Fundus photo — 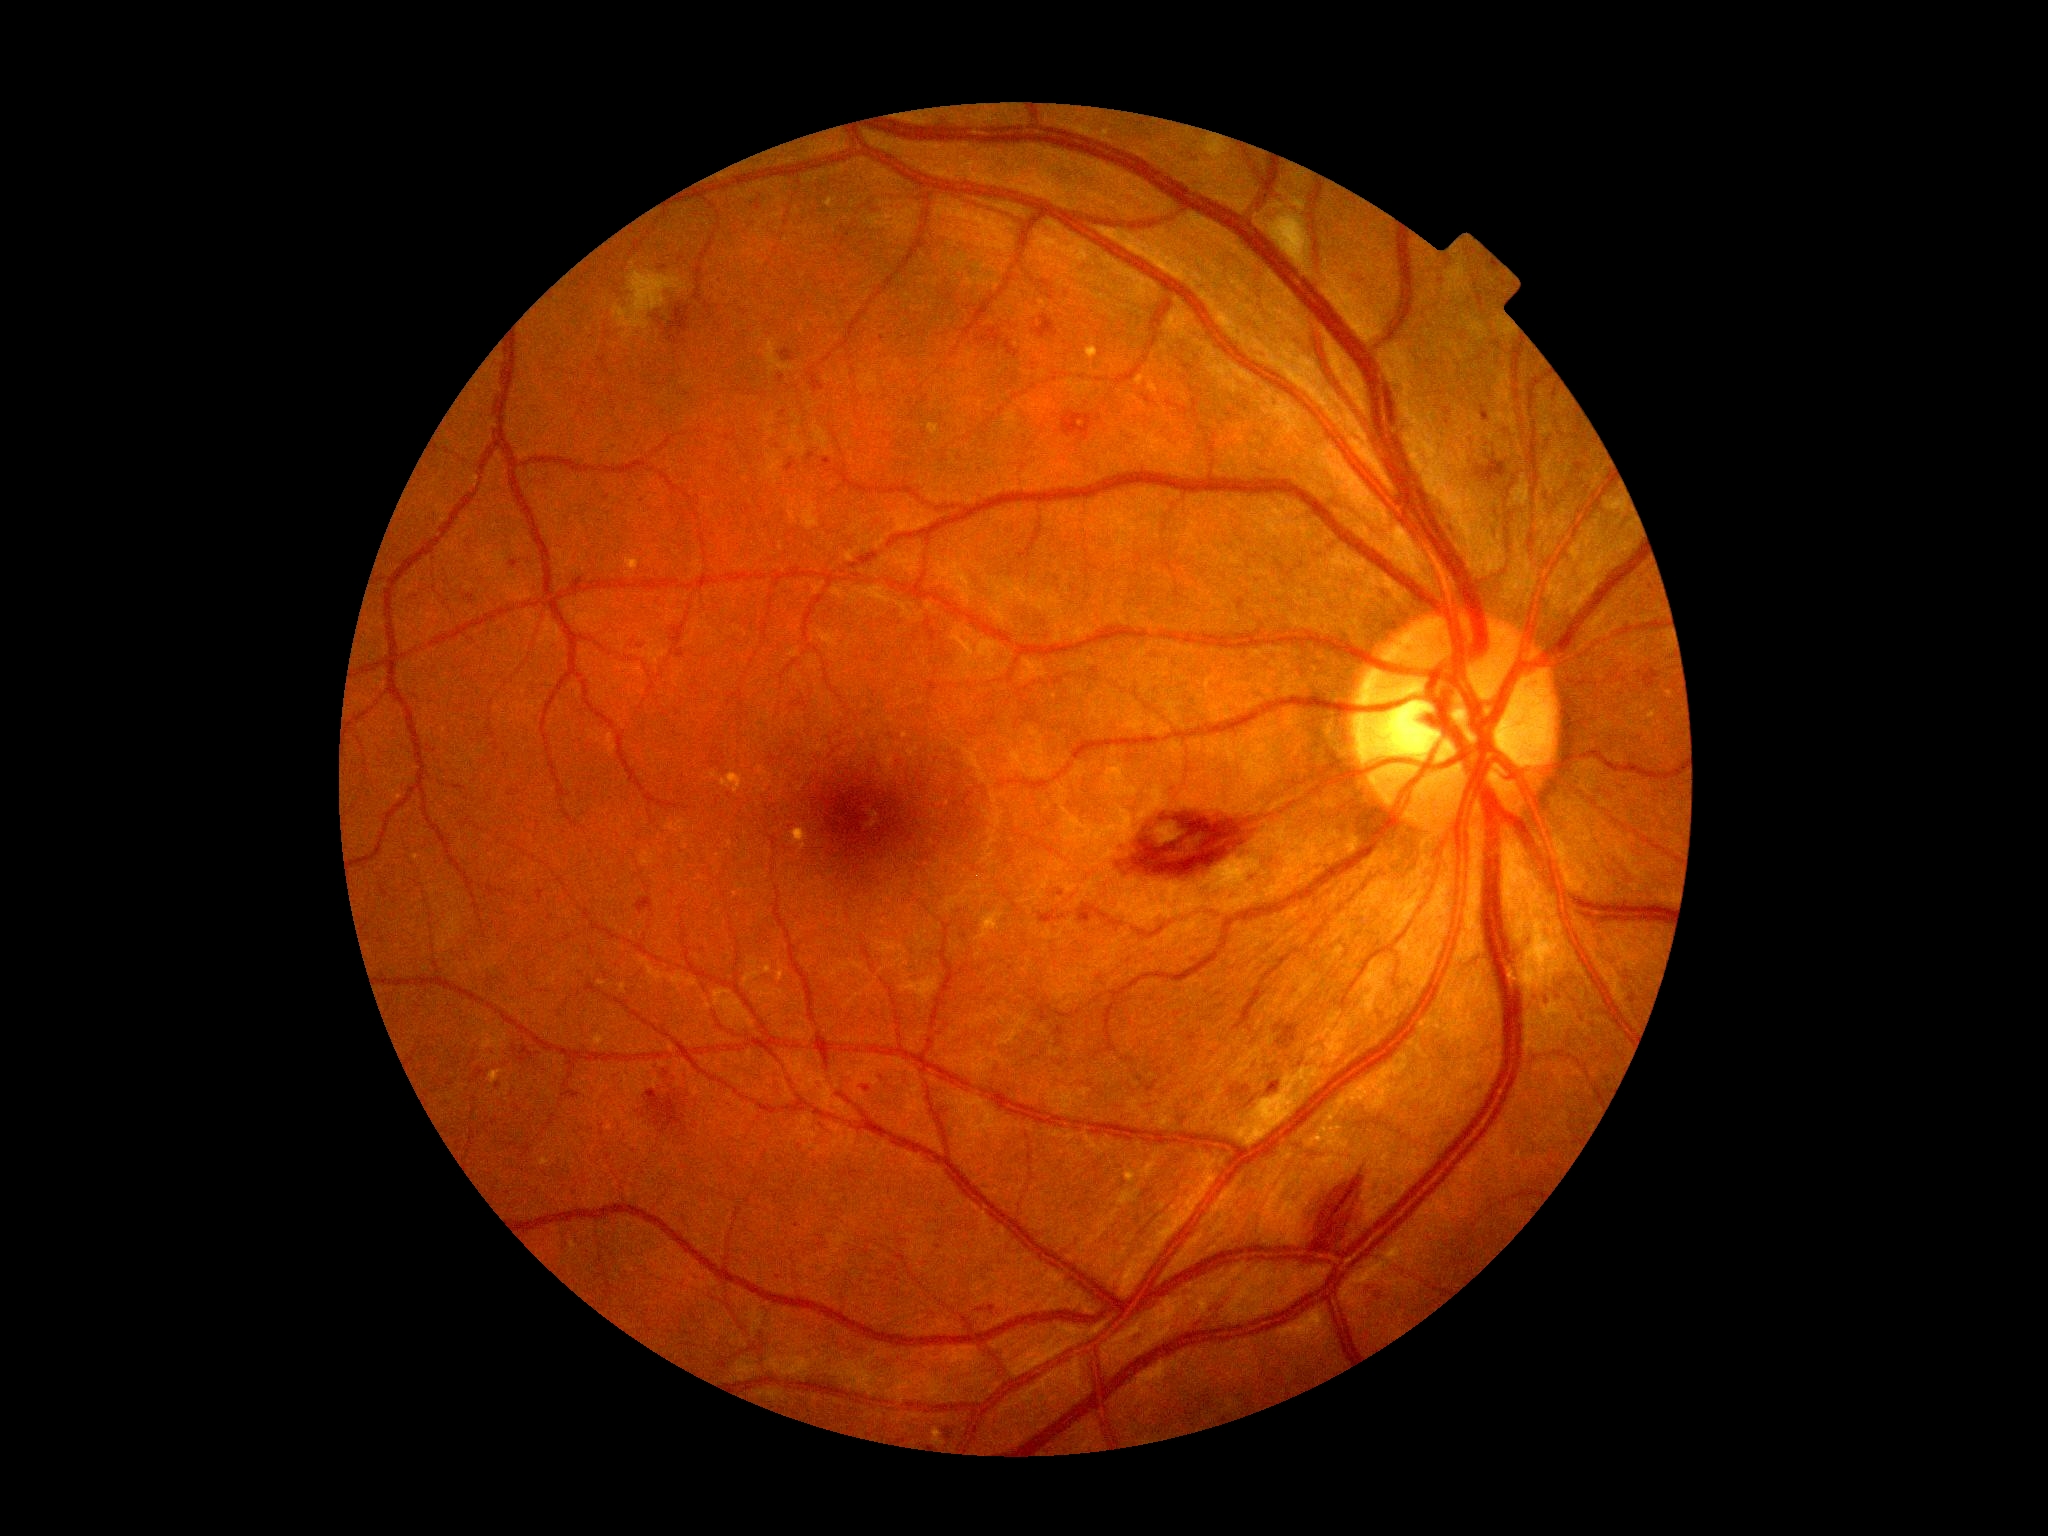 {
  "dr_grade": "2"
}